Retinal fundus photograph. 1932 by 1932 pixels. 45-degree field of view.
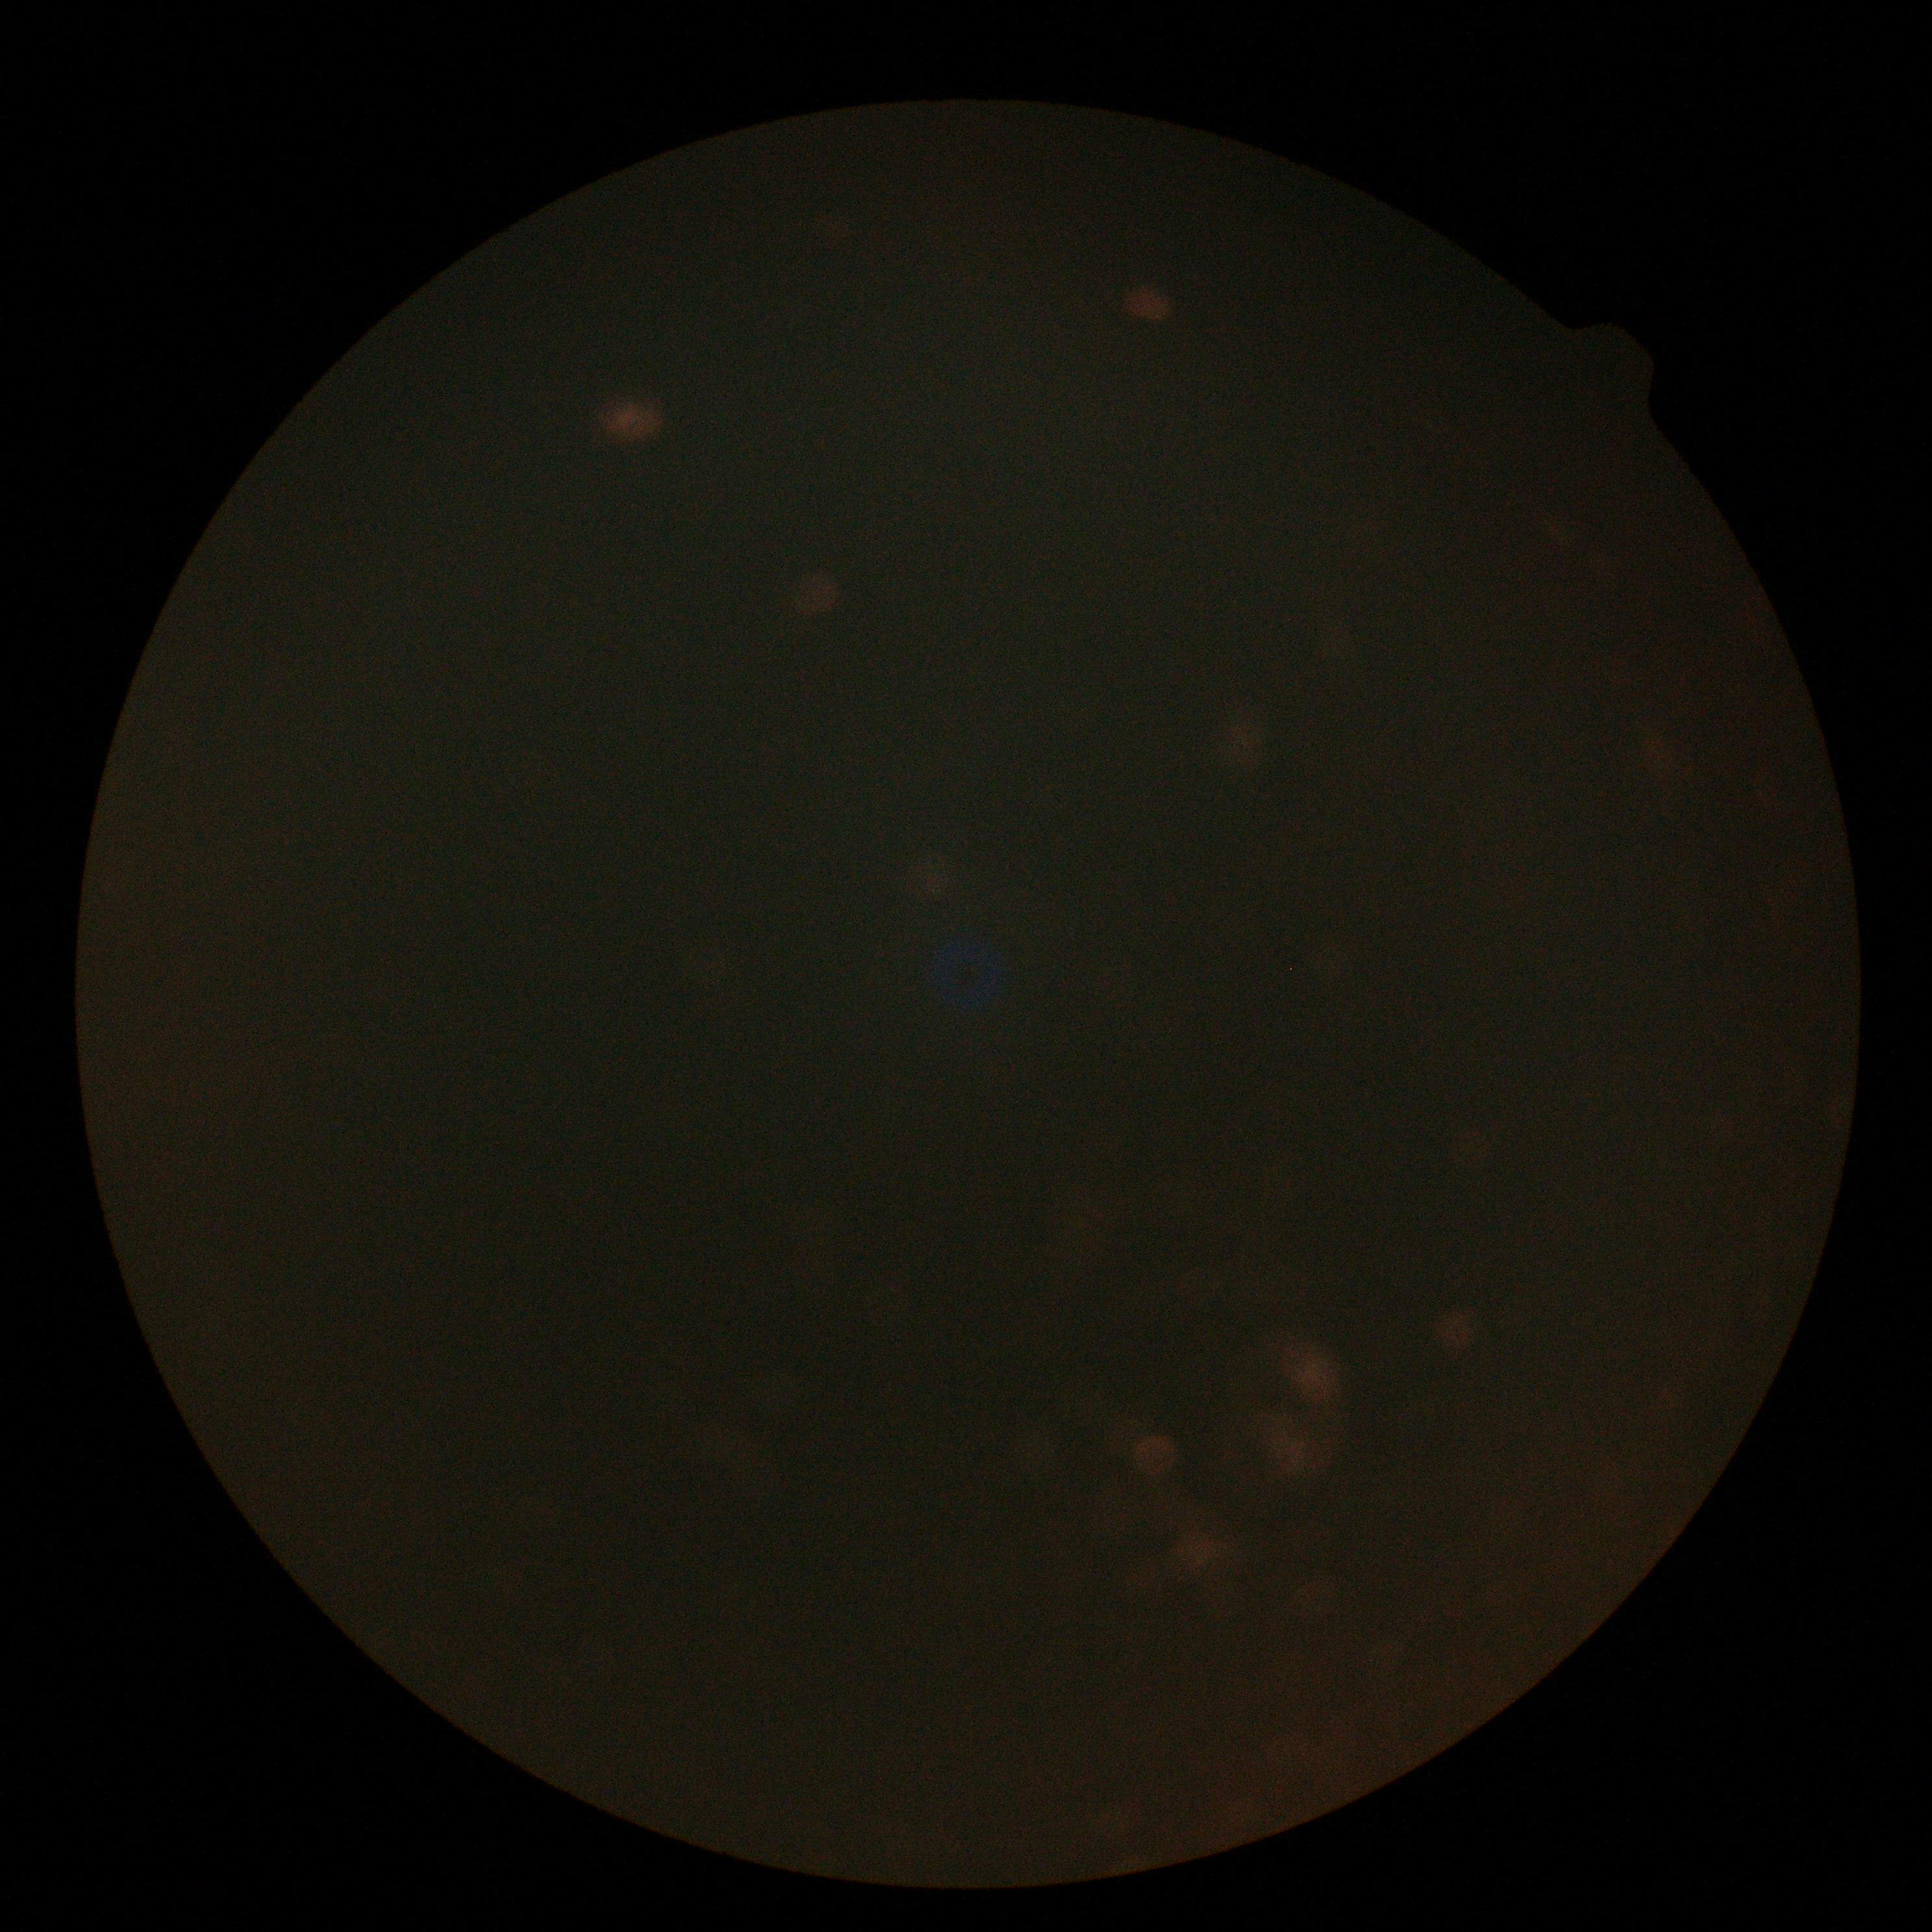
dr_grade: ungradable due to poor image quality
quality: too poor for DR grading